Image size 640x480. Wide-field contact fundus photograph of an infant
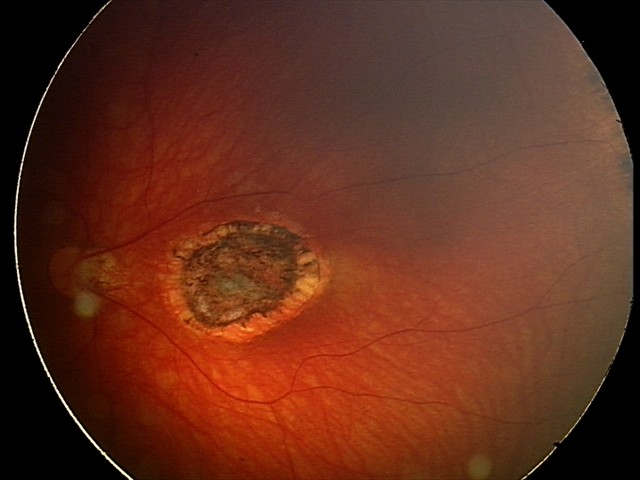

Screening diagnosis: toxoplasmosis chorioretinitis.